45-degree field of view · NIDEK AFC-230 · fundus photo.
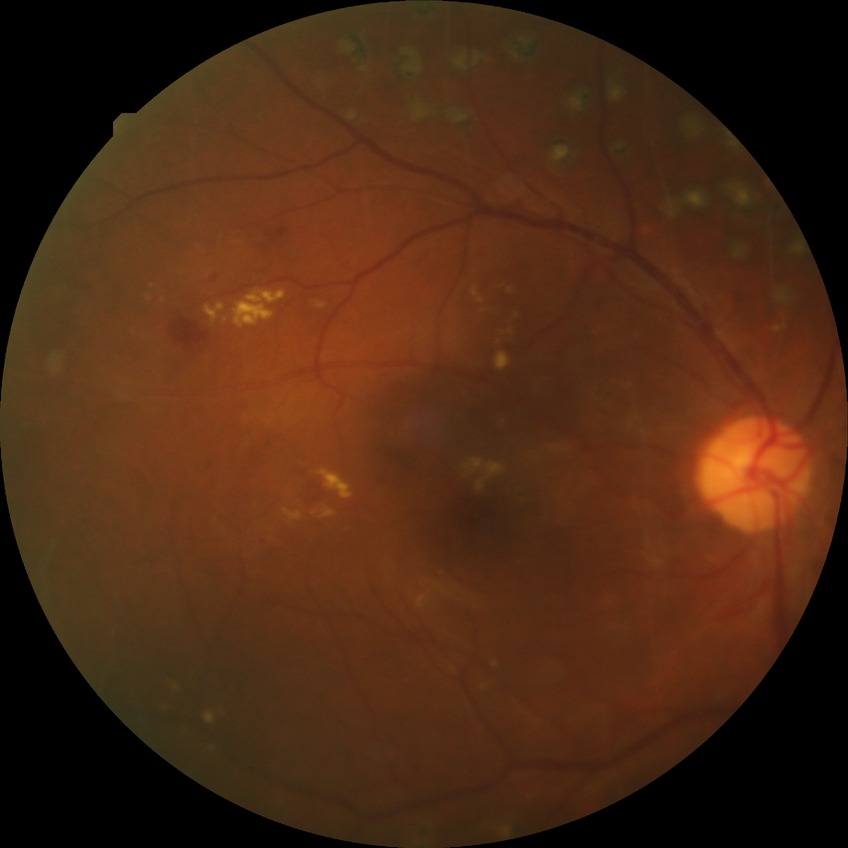 diabetic retinopathy (DR) = PDR (proliferative diabetic retinopathy).